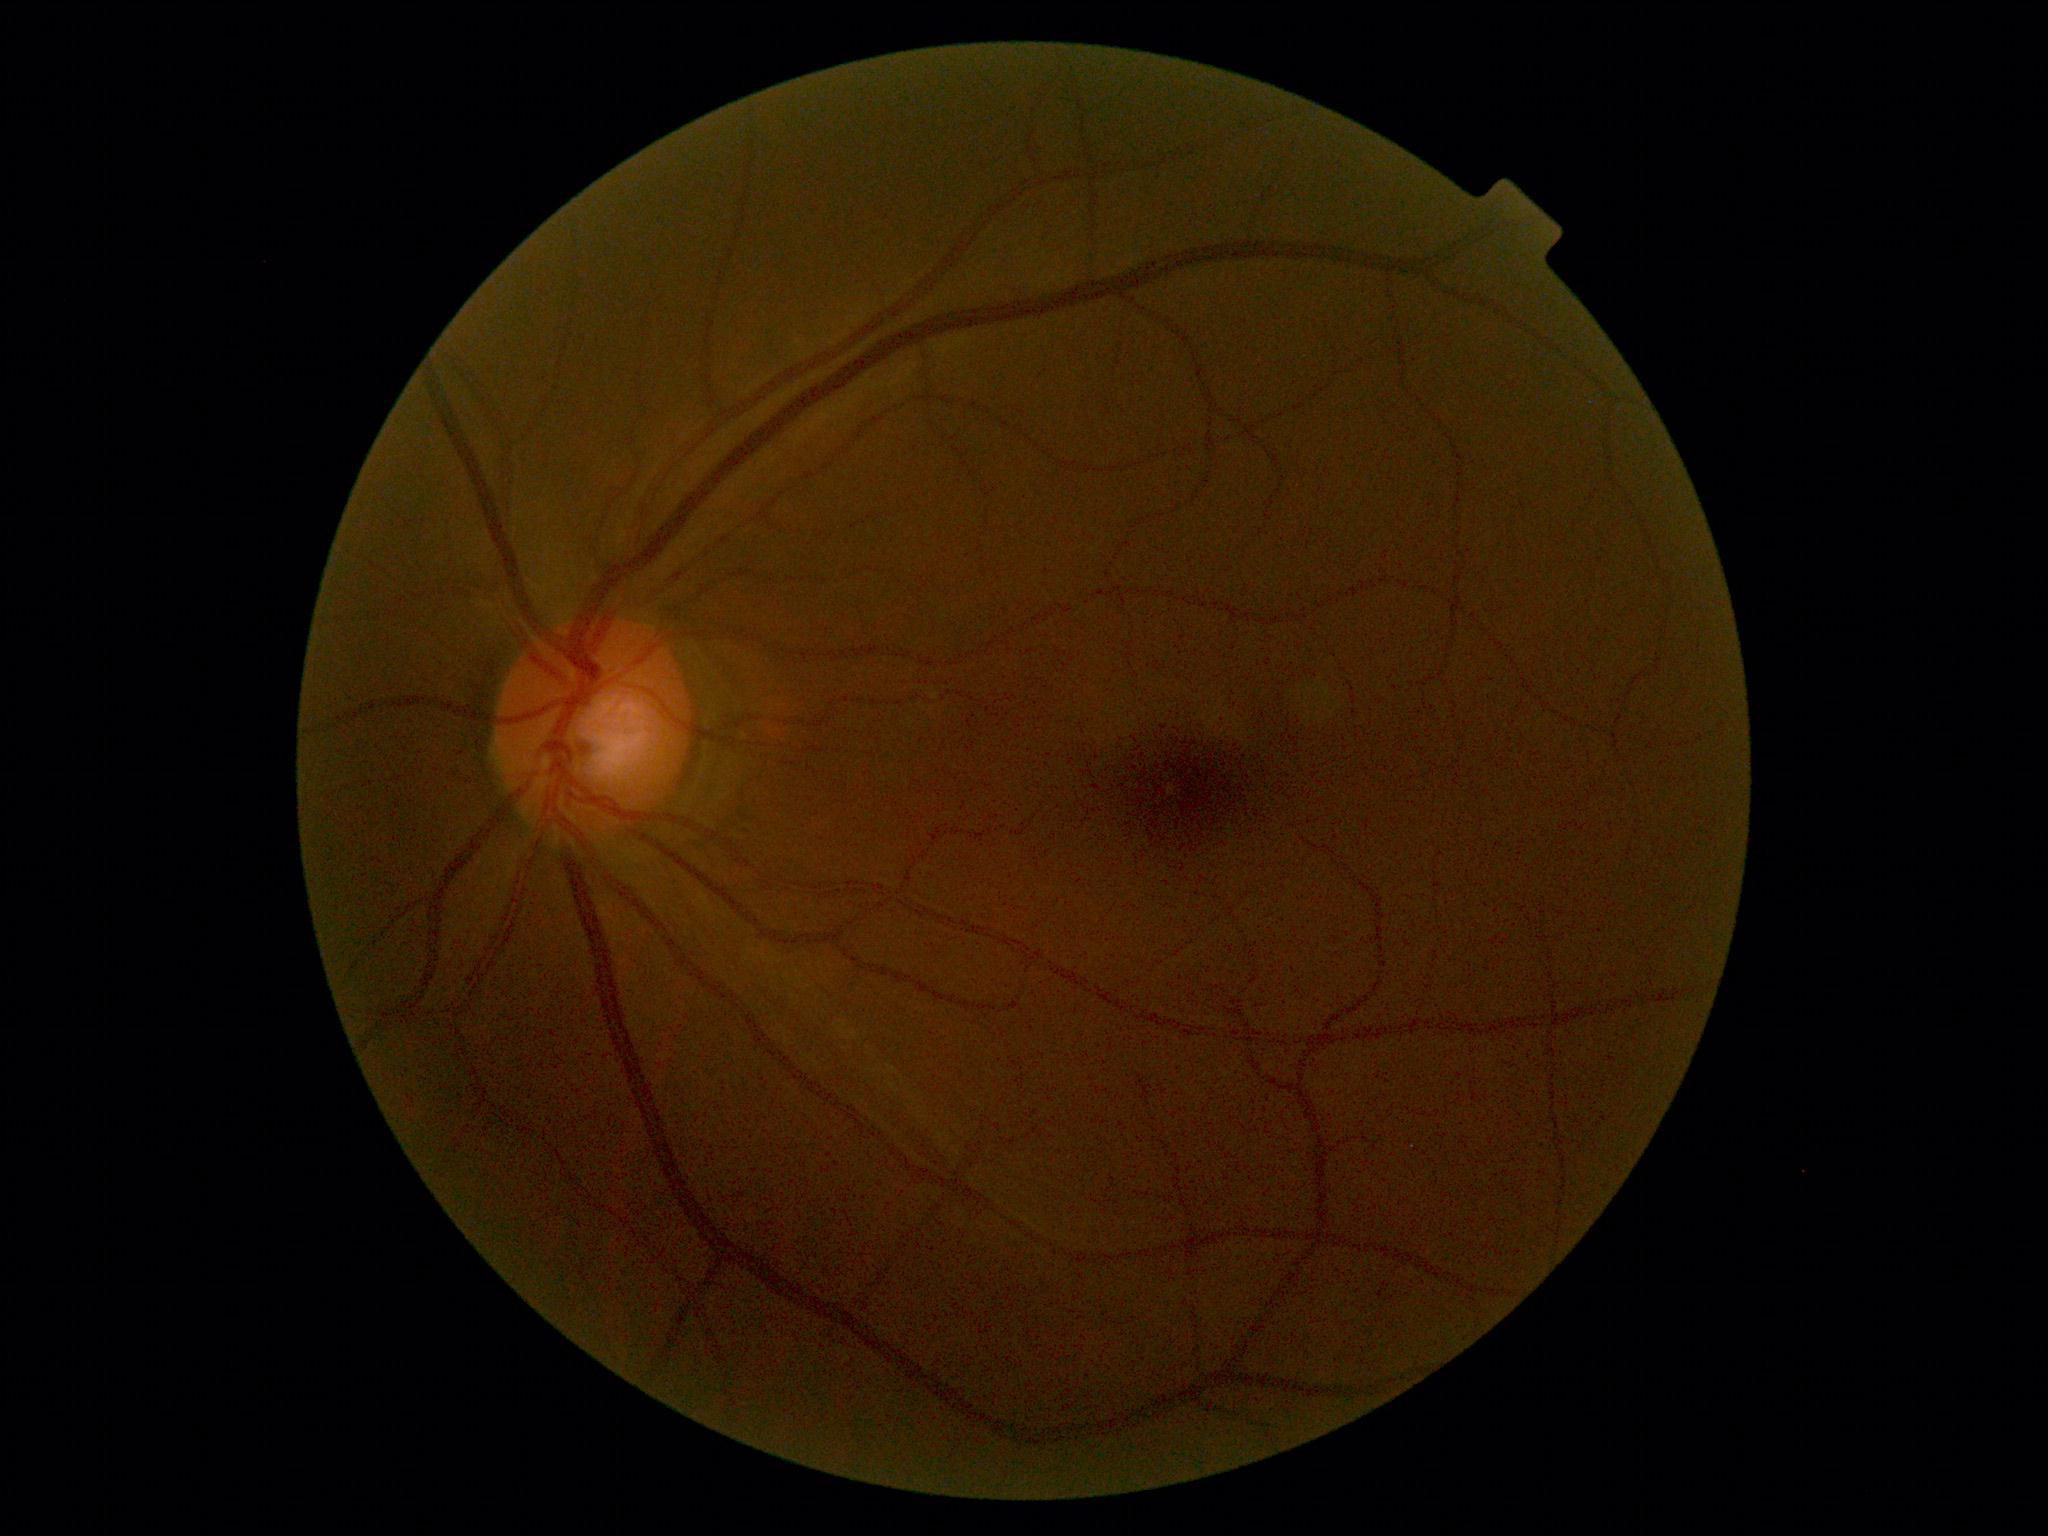
DR: grade 0 (no apparent retinopathy); DR impression: no signs of DR.